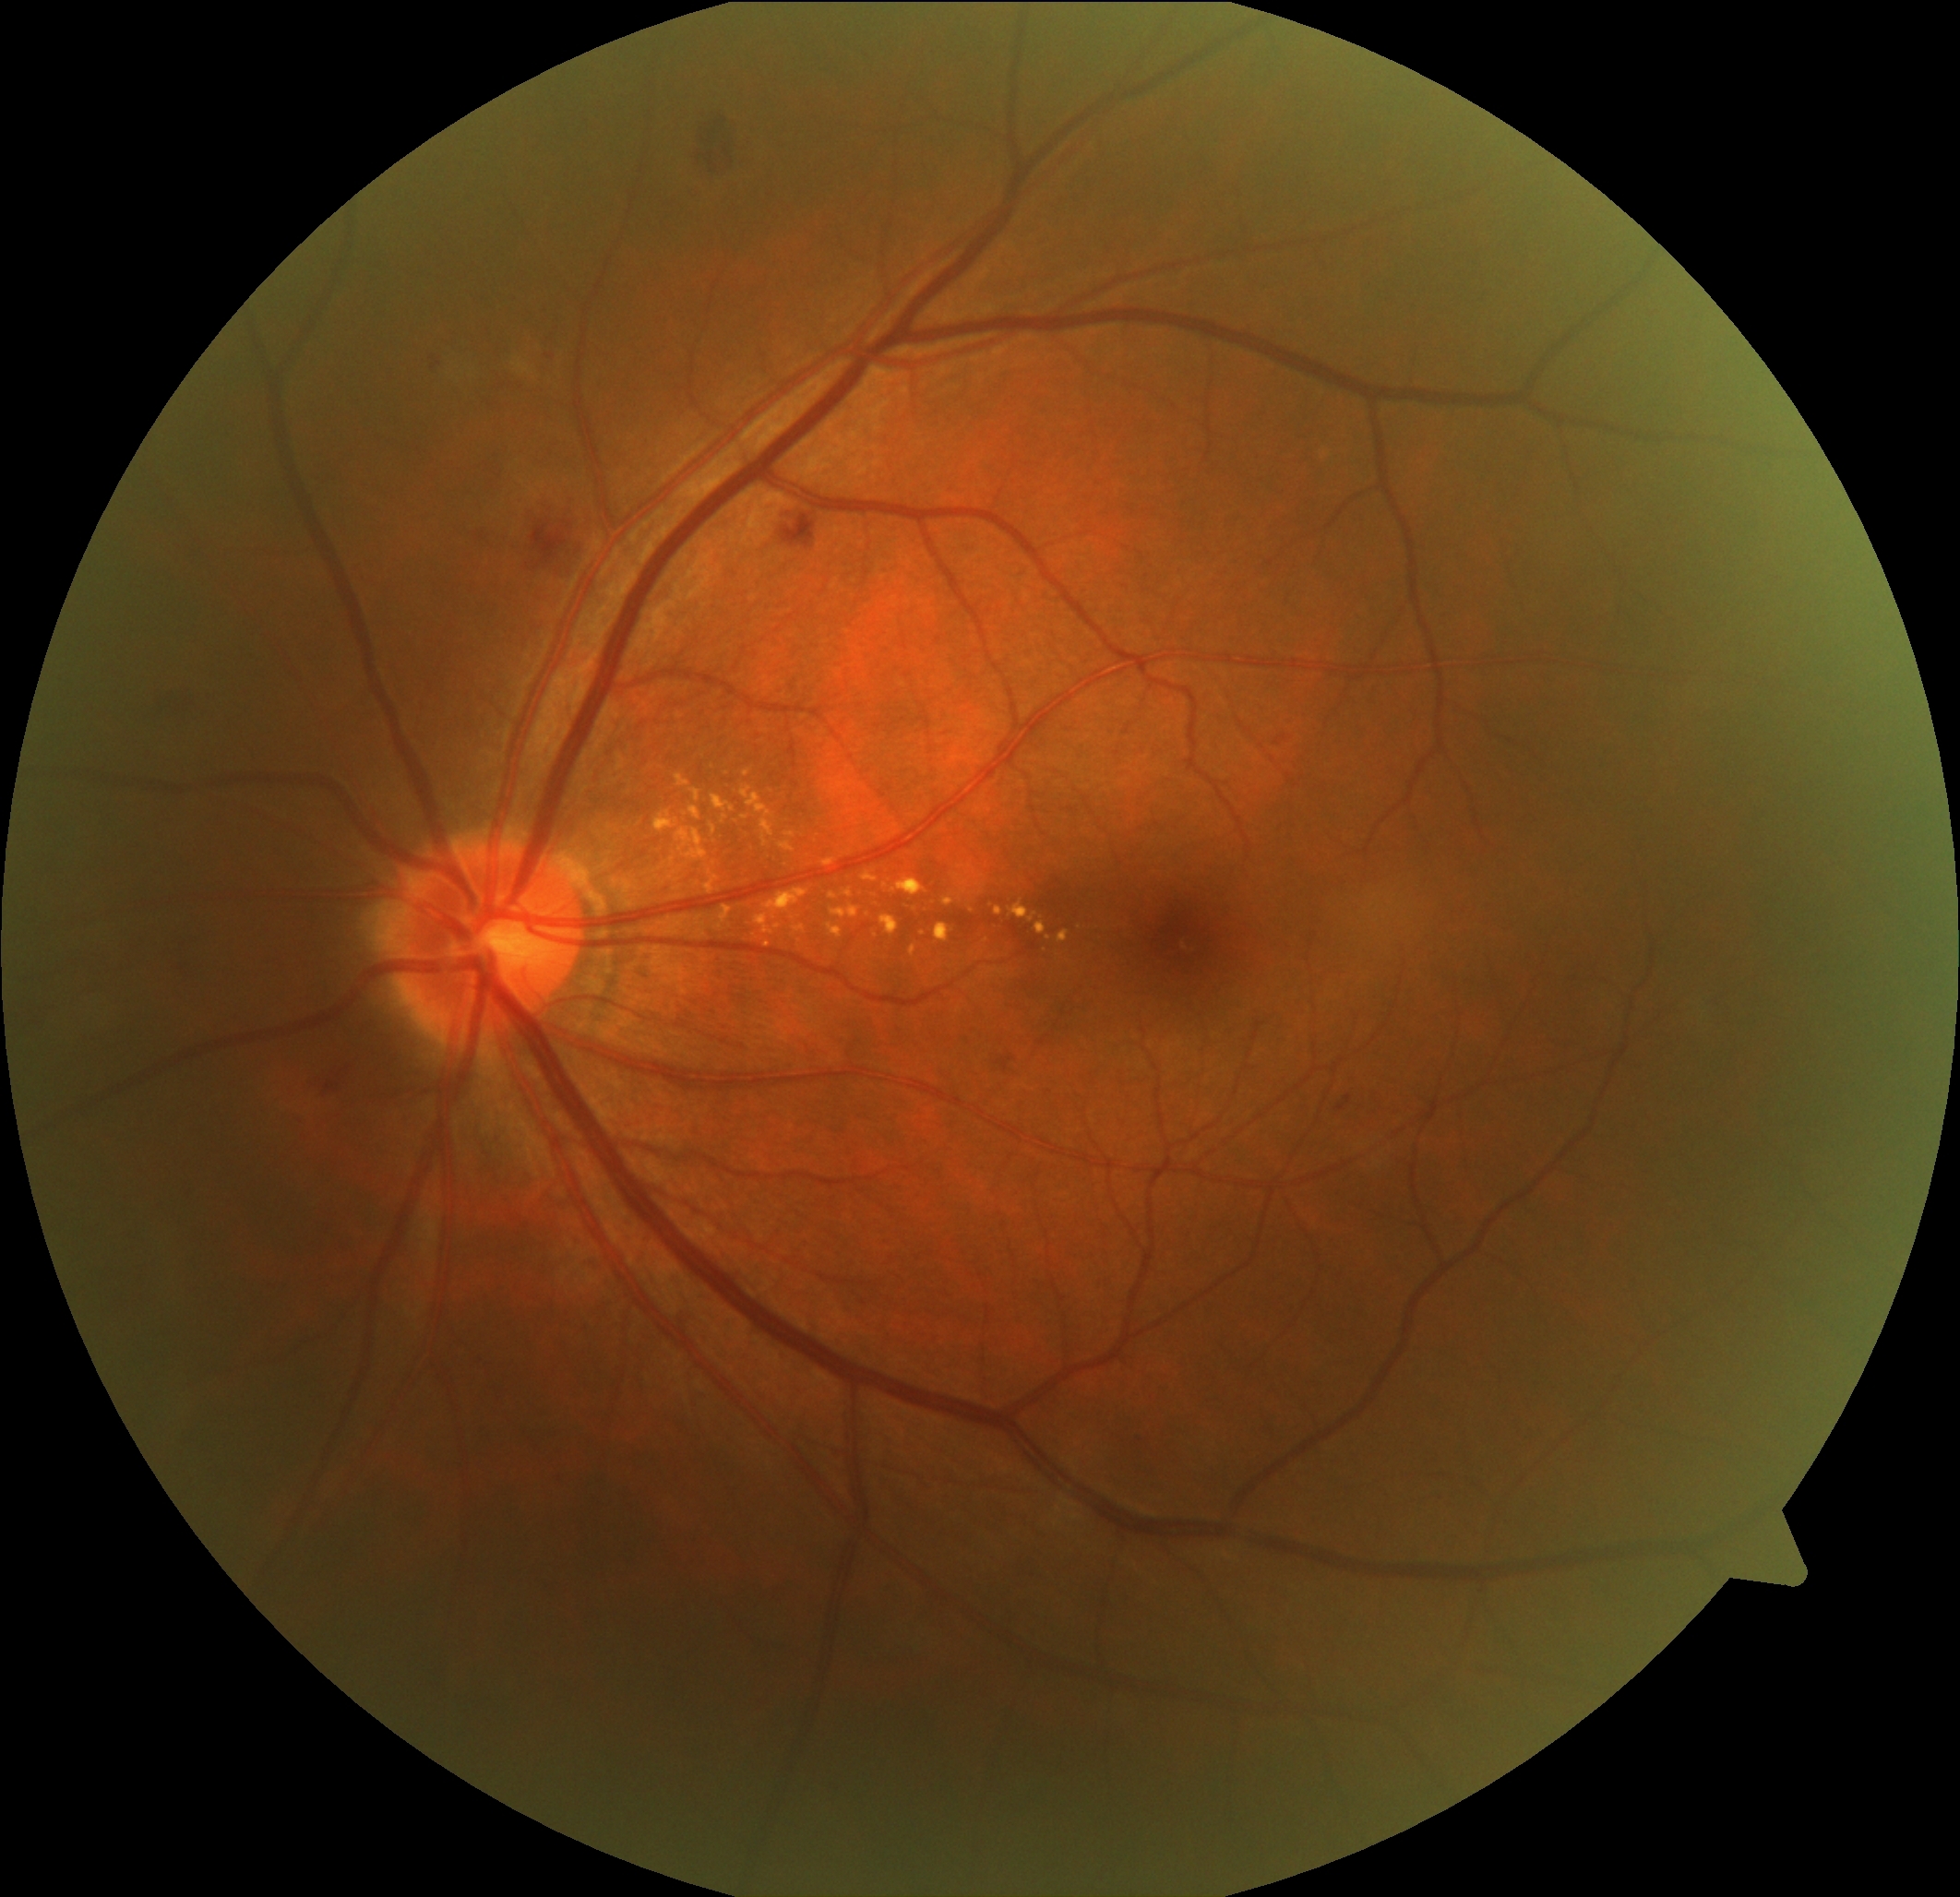 DR grade is 2
A subset of detected lesions:
EXs (partial): 1035 923 1046 936; 827 924 843 939; 862 873 878 884; 785 832 796 838; 693 790 700 802; 1010 903 1037 924; 711 825 718 834; 766 889 809 914; 880 916 900 936; 795 926 806 934; 936 925 953 943; 762 916 773 936; 996 907 1003 916; 843 889 854 900
EXs (small, approximate centers) near (x=745, y=819); (x=778, y=927); (x=972, y=911)